Natus RetCam Envision, 130° FOV. Wide-field contact fundus photograph of an infant. 1440x1080px — 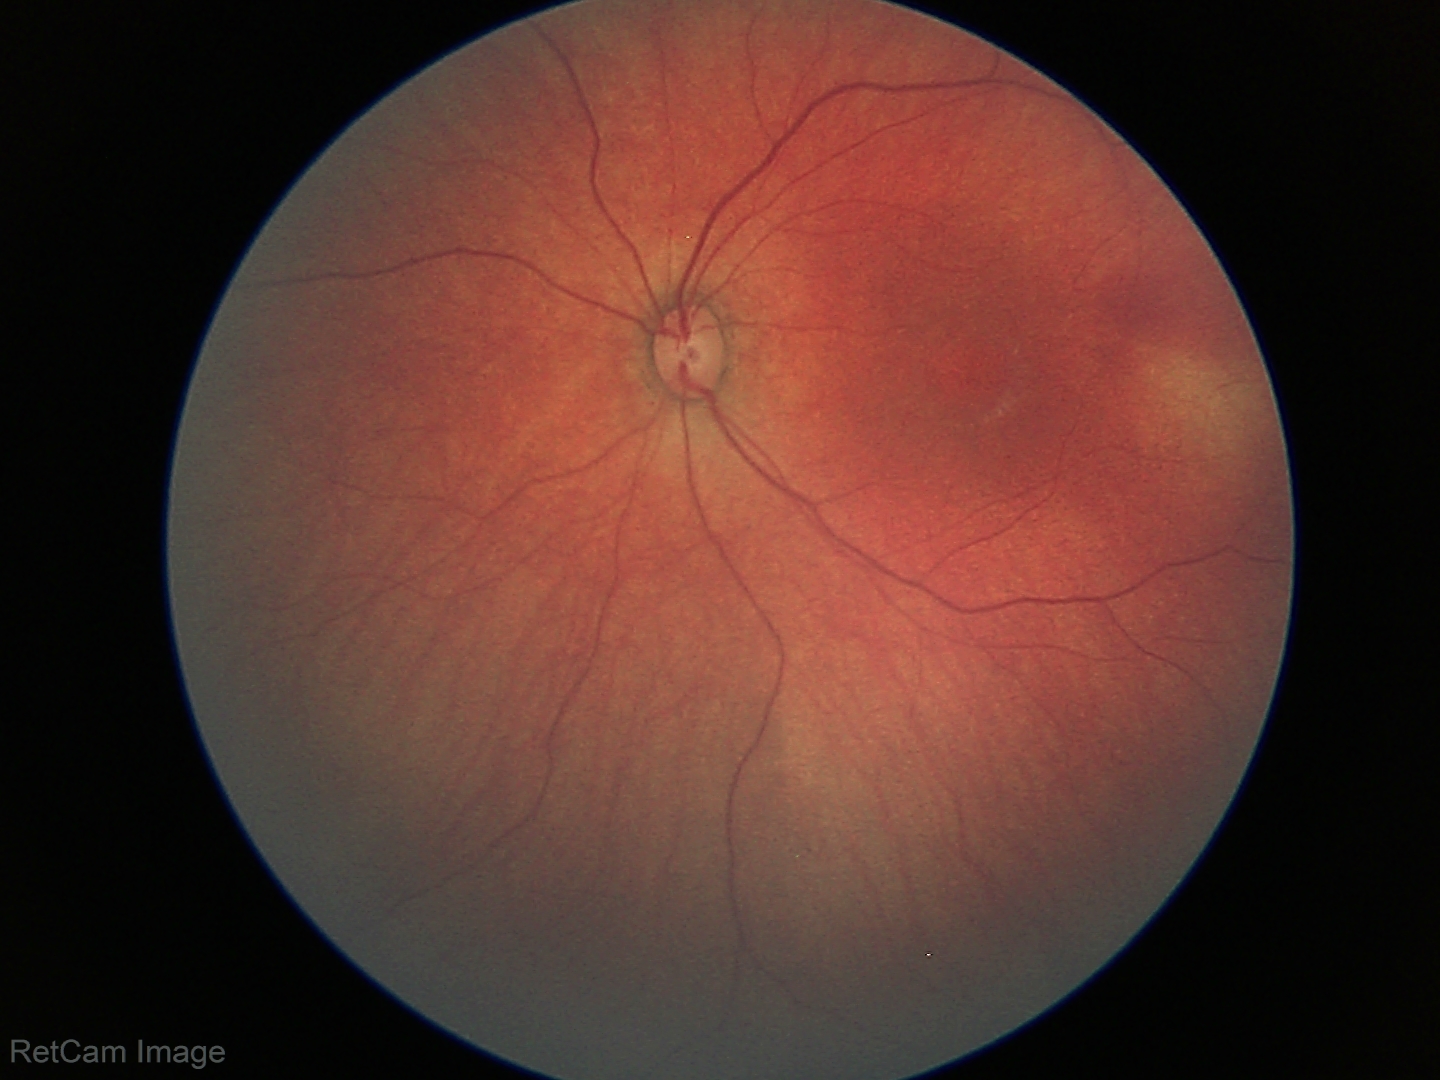 Screening examination with no abnormal retinal findings.